45 degree fundus photograph. Image size 848x848: 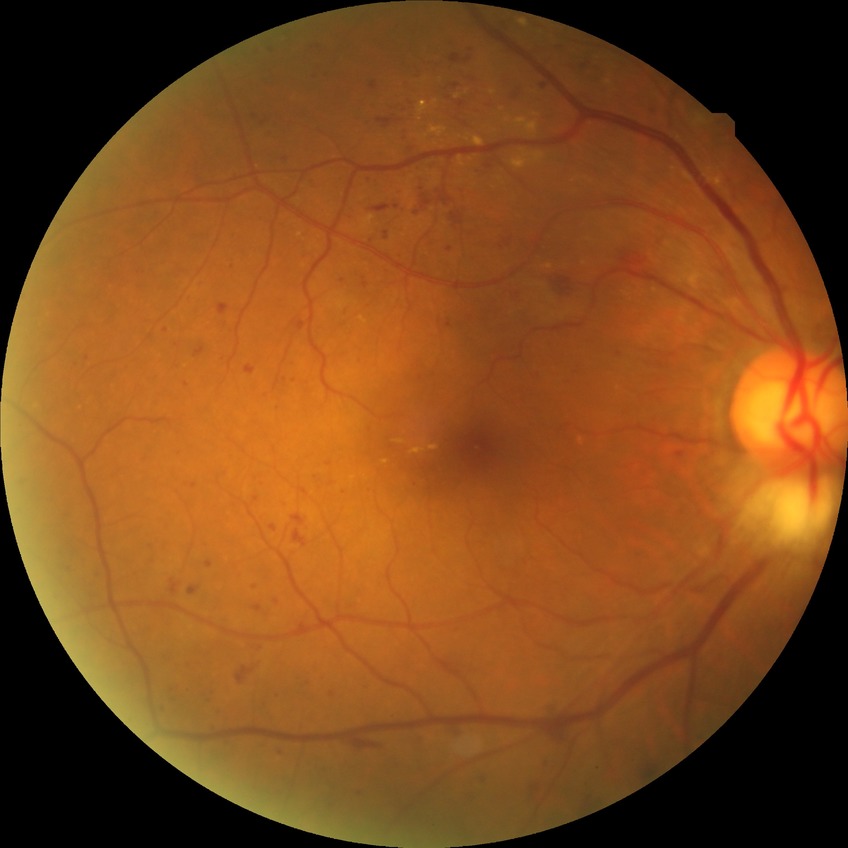
Retinopathy grade is simple diabetic retinopathy.